Optic nerve head crop:
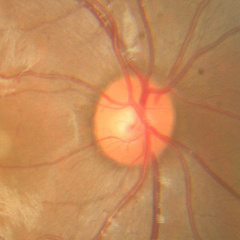 Q: Is glaucoma present?
A: No glaucoma.